848 x 848 pixels; acquired with a NIDEK AFC-230:
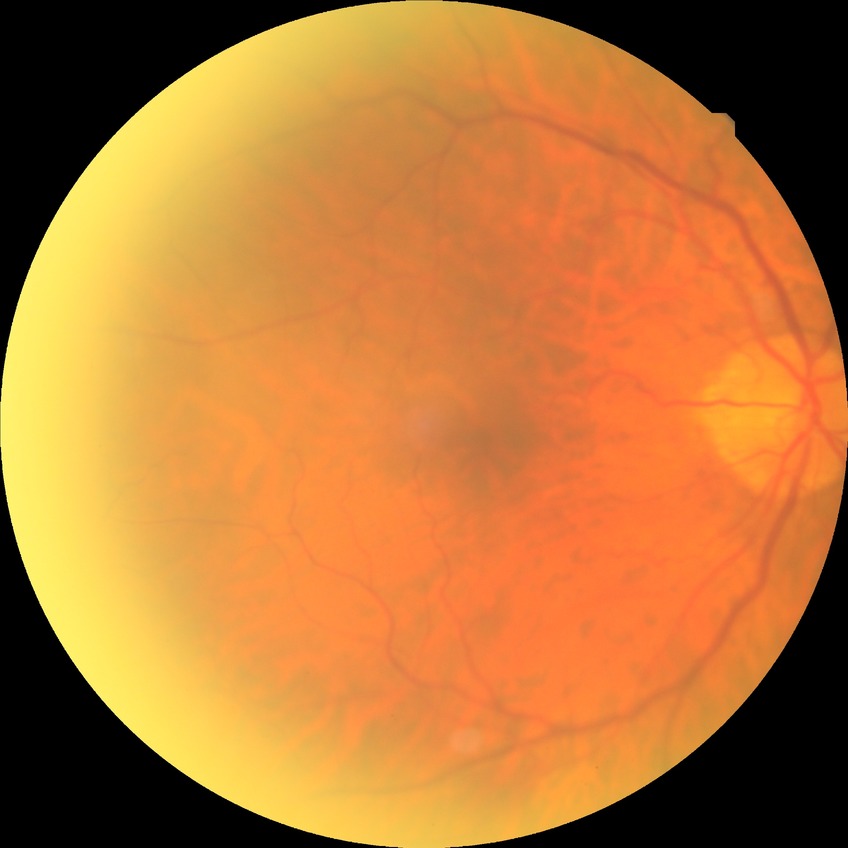 modified Davis grading@no diabetic retinopathy.